Modified Davis grading, NIDEK AFC-230:
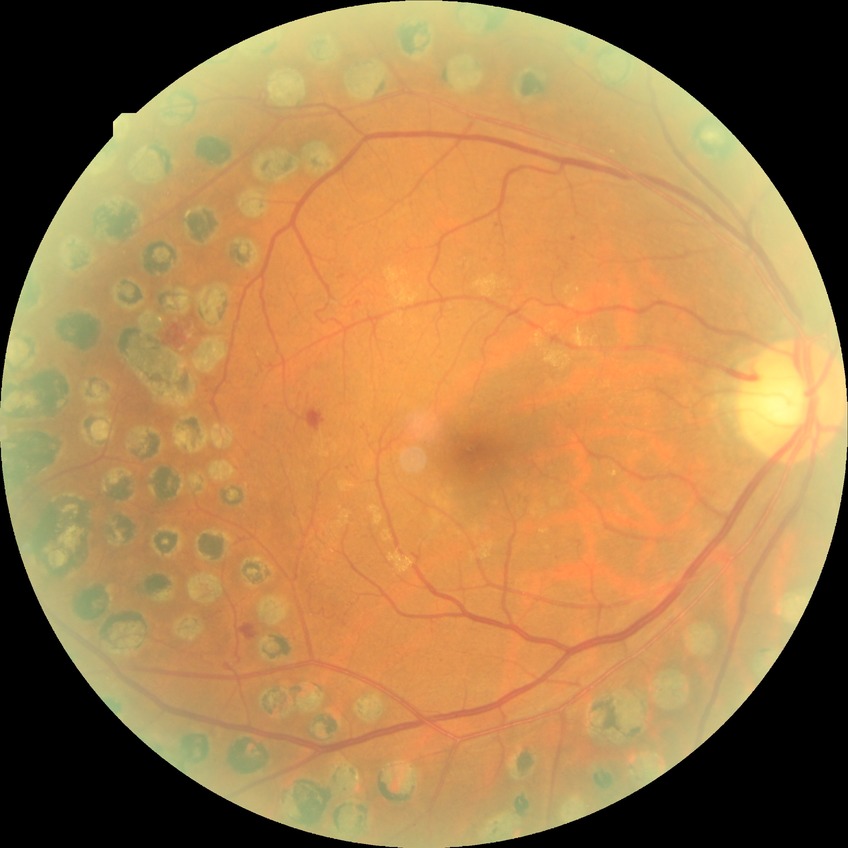

  davis_grade: proliferative diabetic retinopathy